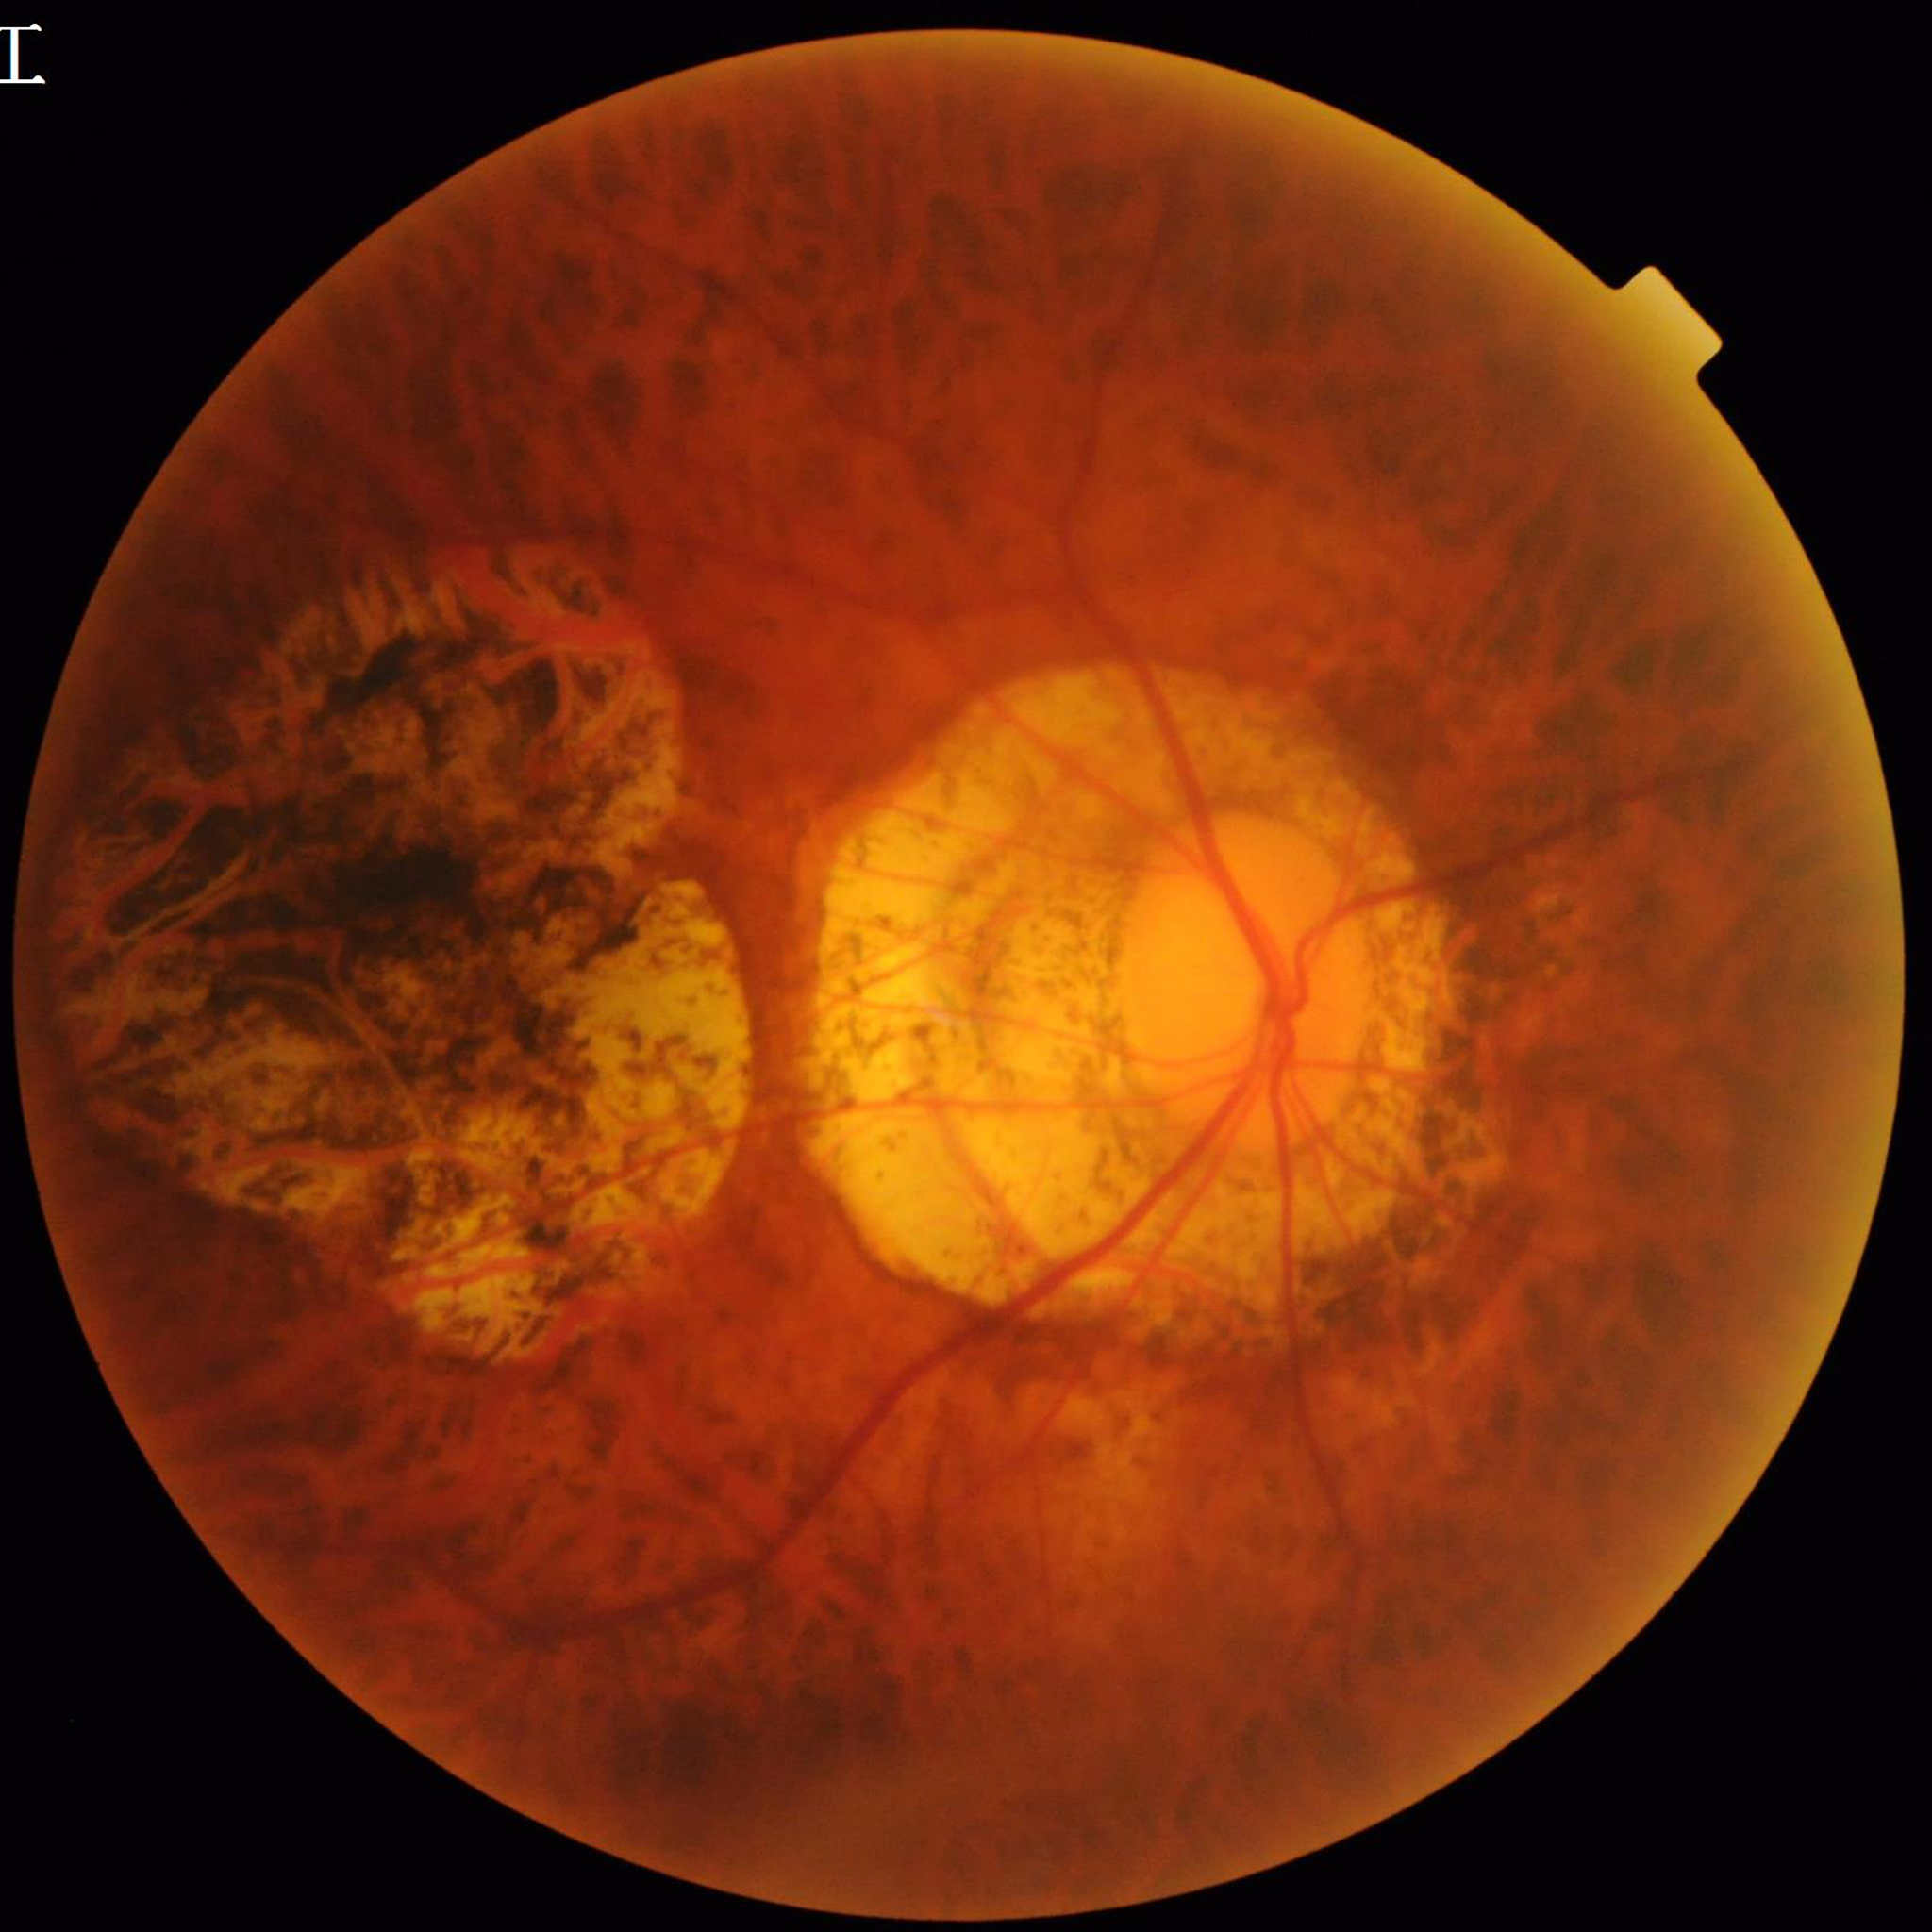
Quality assessment: no quality issues identified | Diagnosis: age-related macular degeneration.